FOV: 50 degrees: 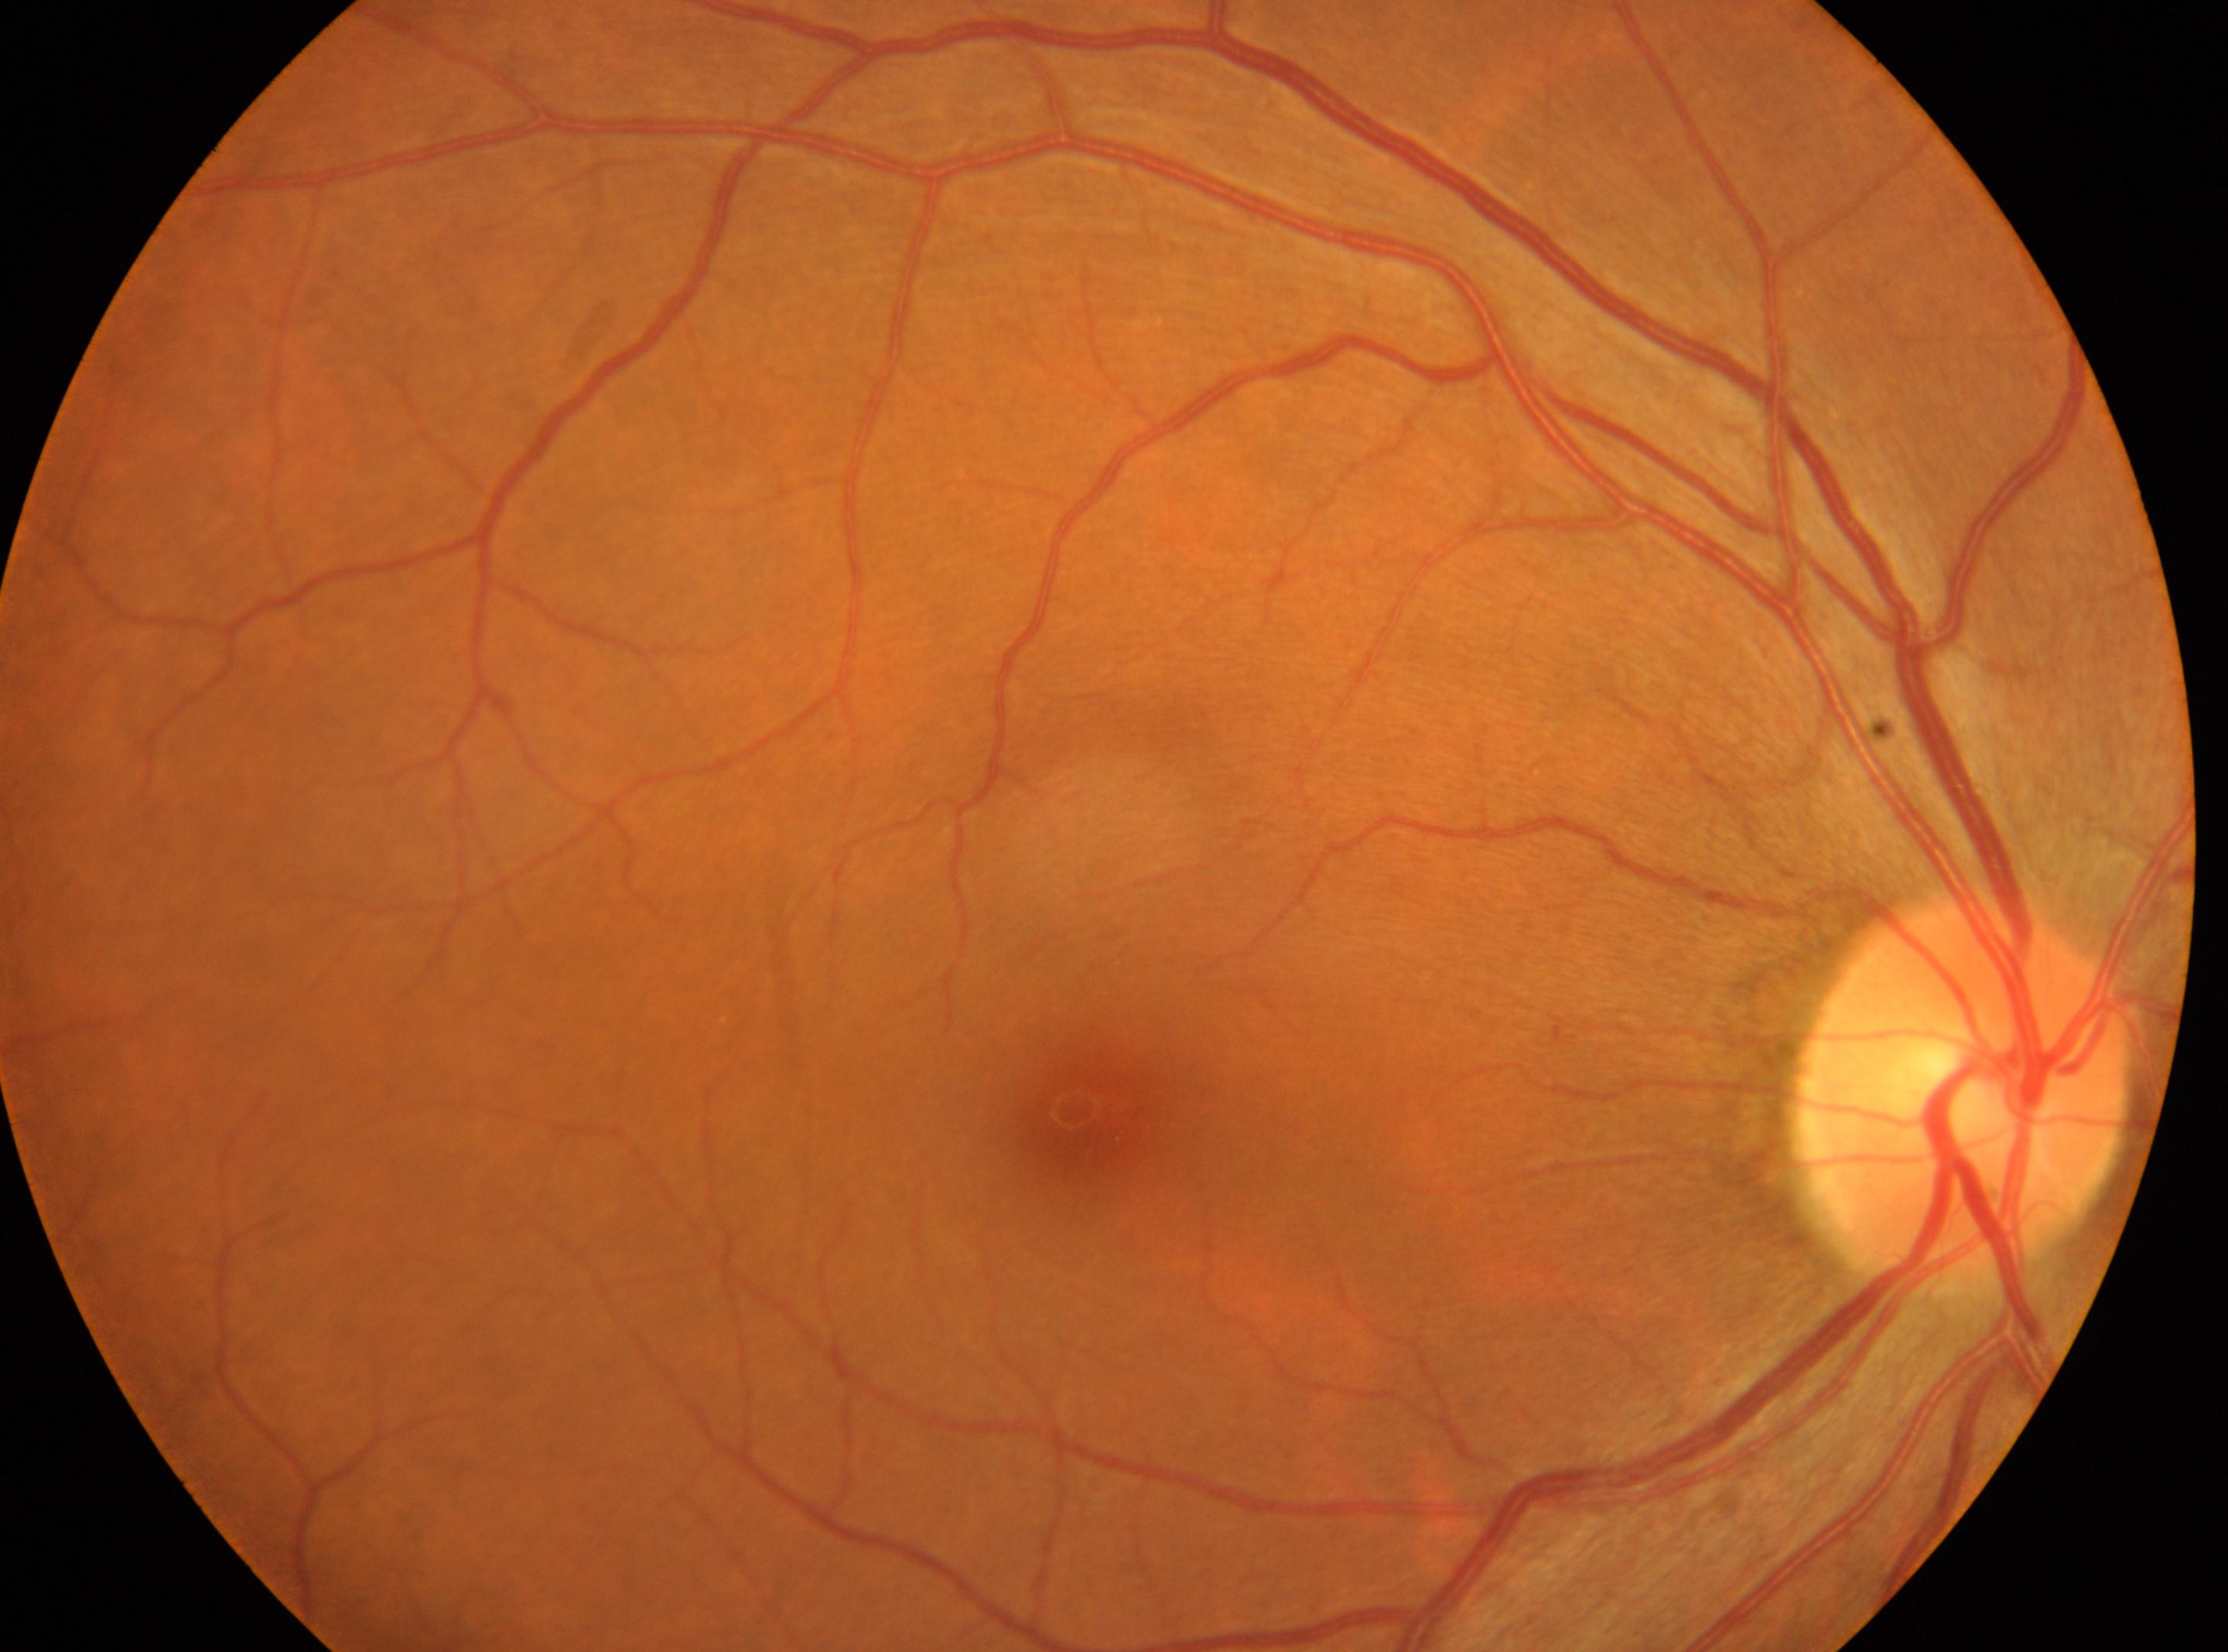 Eye: OD.
Fovea: (x: 1082, y: 1117).
The disc center is at (x: 1959, y: 1087).
DR stage is 0/4.